Acquired with a NIDEK AFC-230.
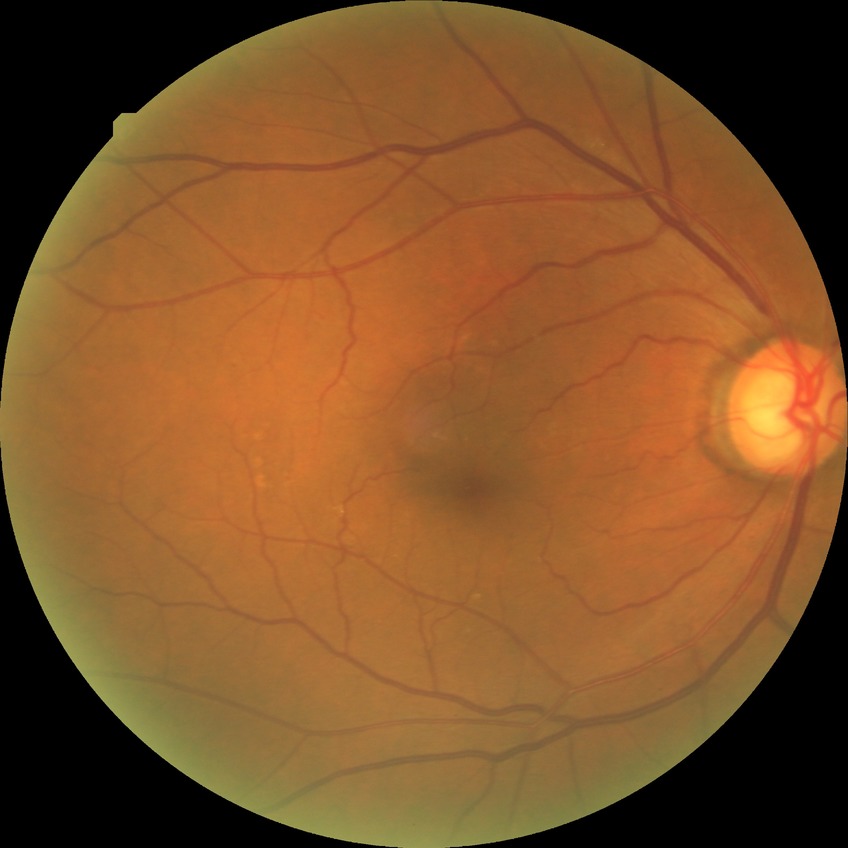 Diabetic retinopathy (DR) is NDR (no diabetic retinopathy).